Wide-field fundus photograph of an infant — 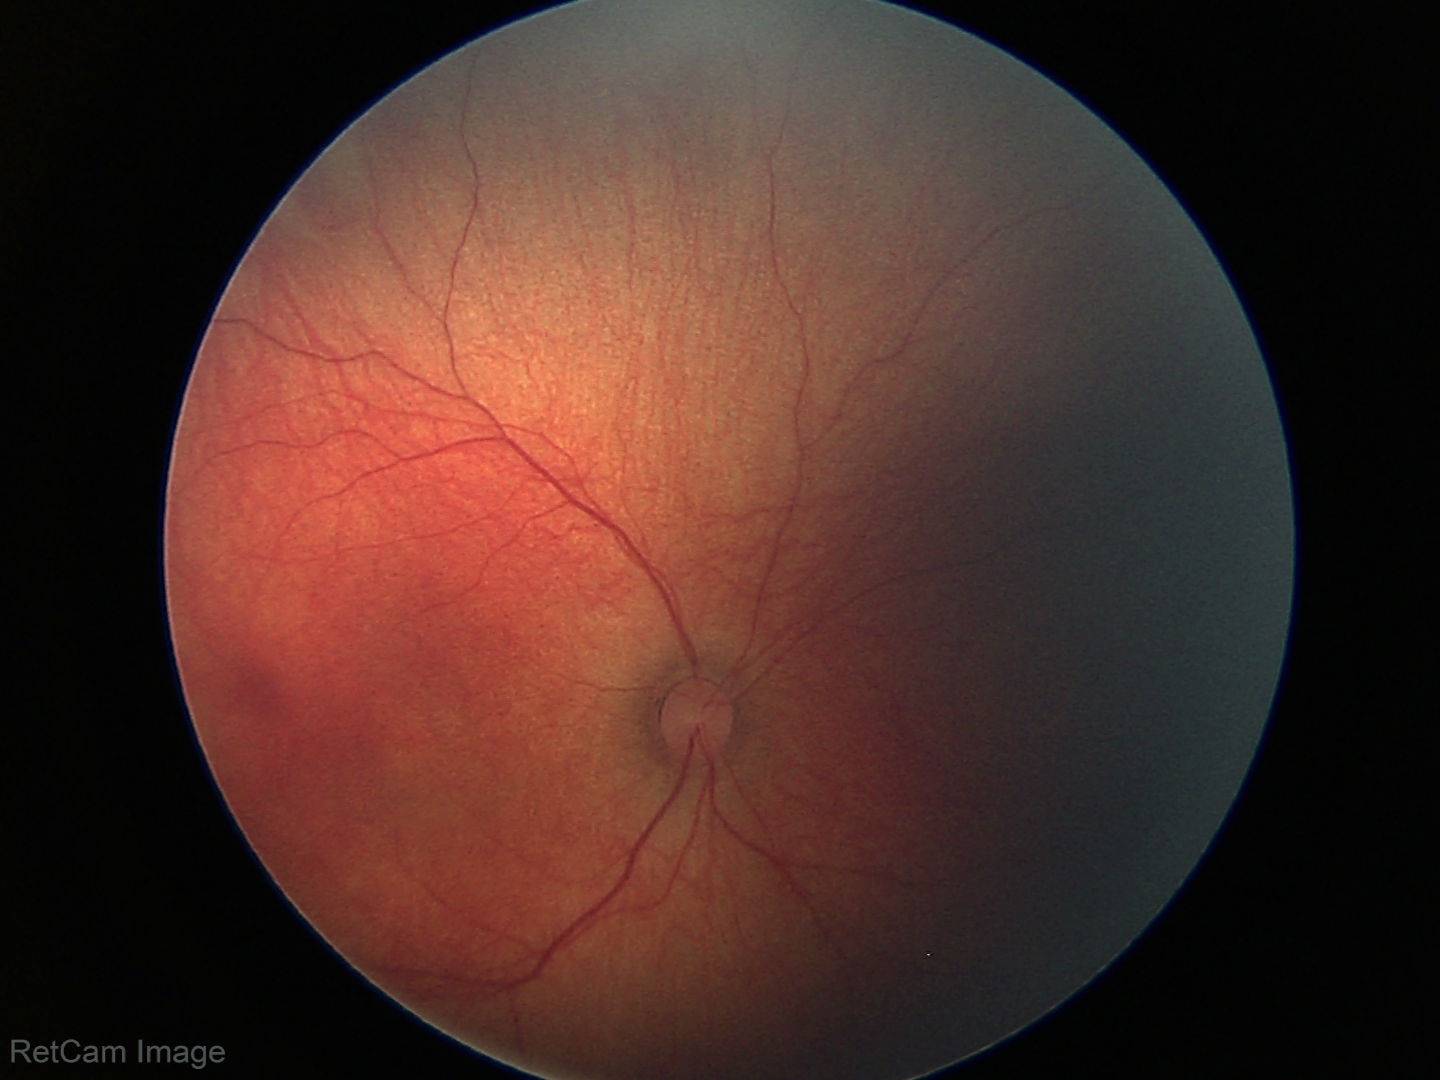
Screening examination with no abnormal retinal findings.